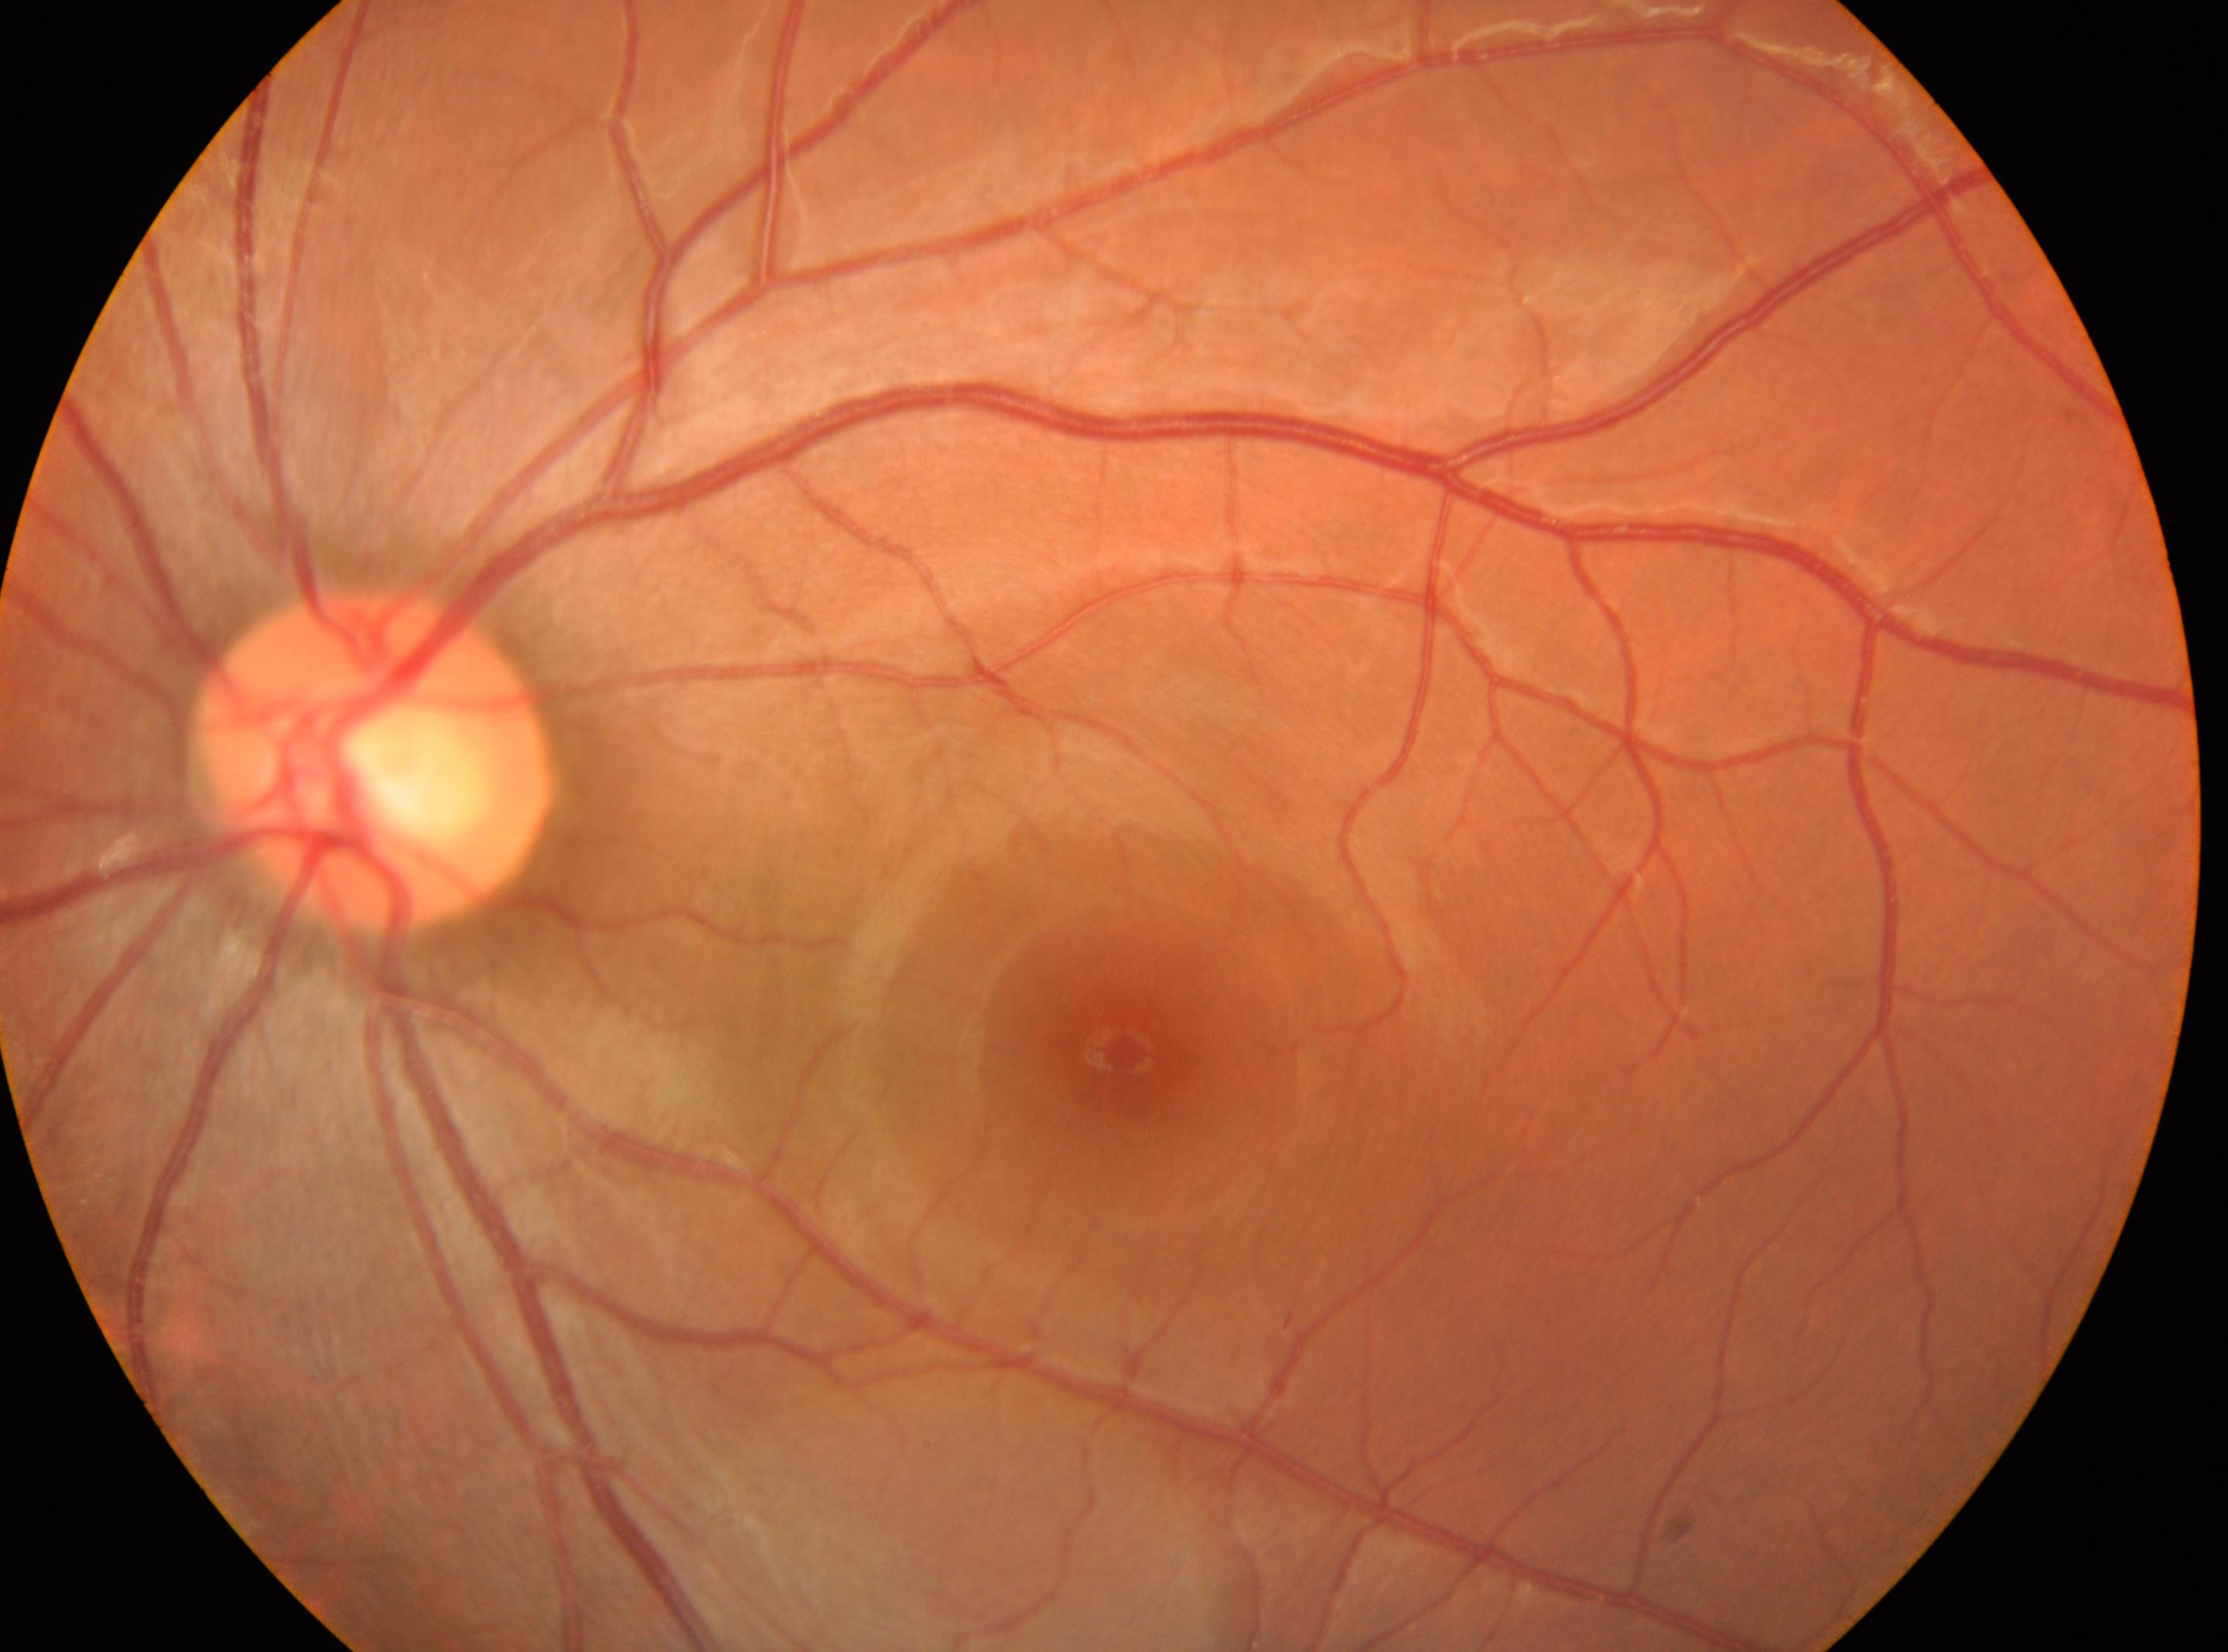
Fovea: x=1120, y=1050.
The optic disc center is at x=373, y=759.
DR grade is no apparent diabetic retinopathy (0).
Eye: oculus sinister.